1932x1932.
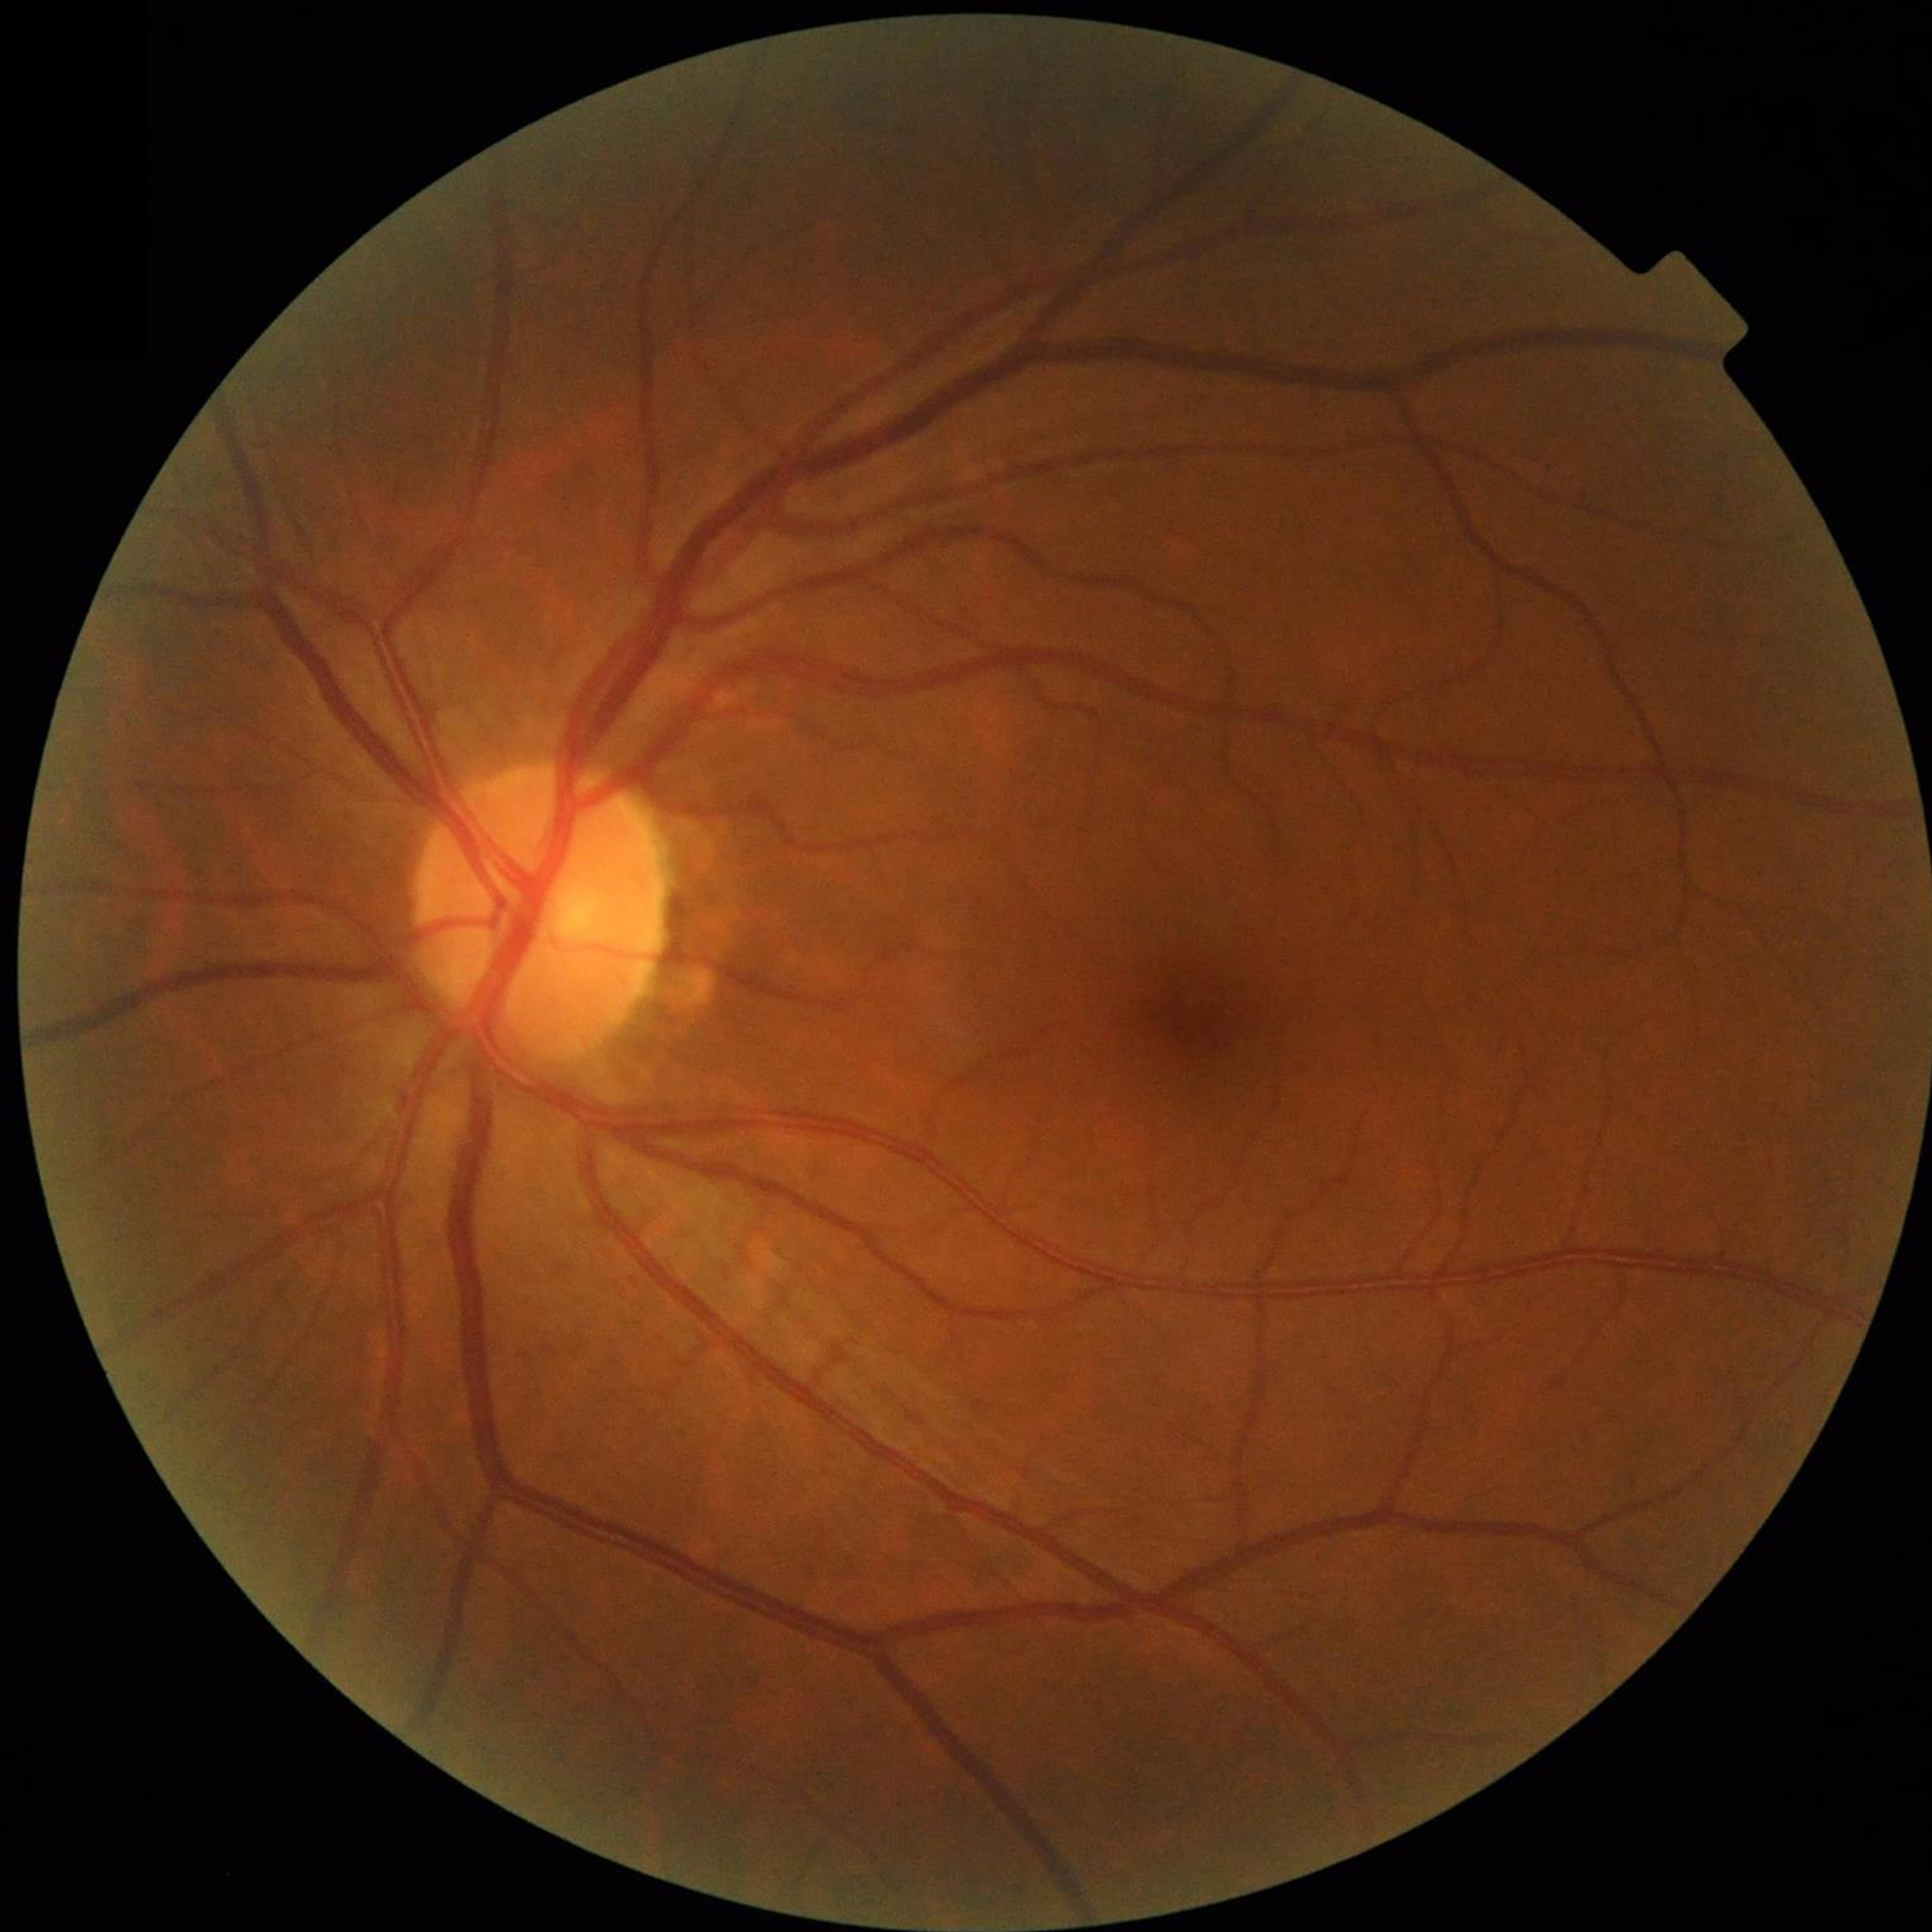
Impression: no AMD, diabetic retinopathy, or glaucoma
Photo quality: contrast adequate, illumination and color satisfactory, no blur